FOV: 45 degrees. Posterior pole color fundus photograph. Camera: NIDEK AFC-230. Without pupil dilation. 848 by 848 pixels
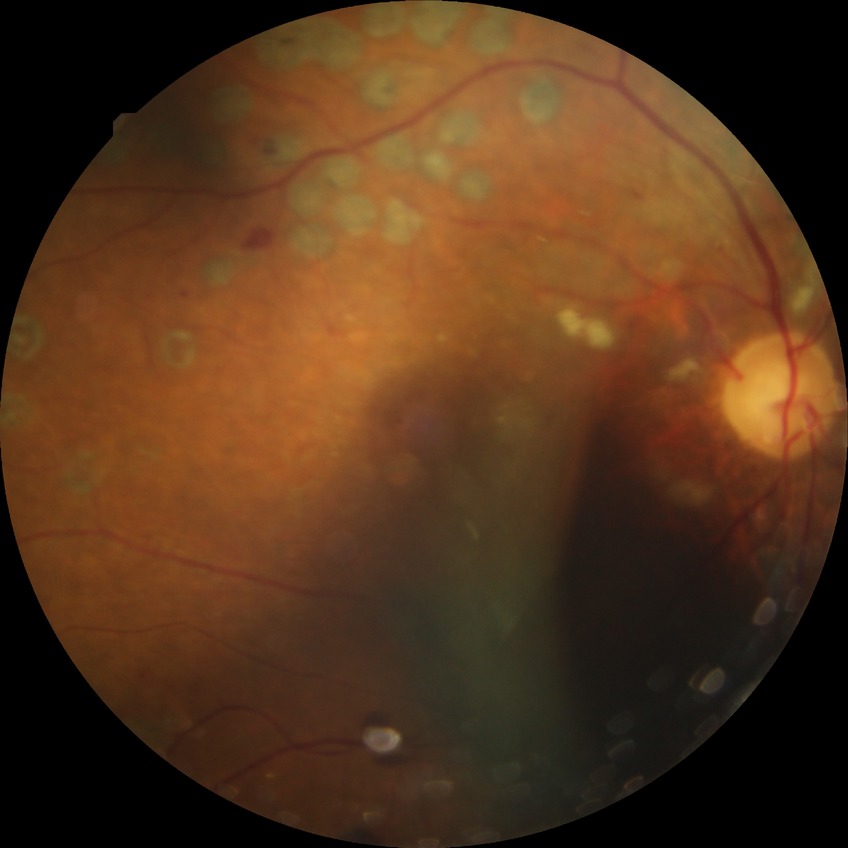

Diabetic retinopathy (DR): proliferative diabetic retinopathy (PDR).